Nonmydriatic: 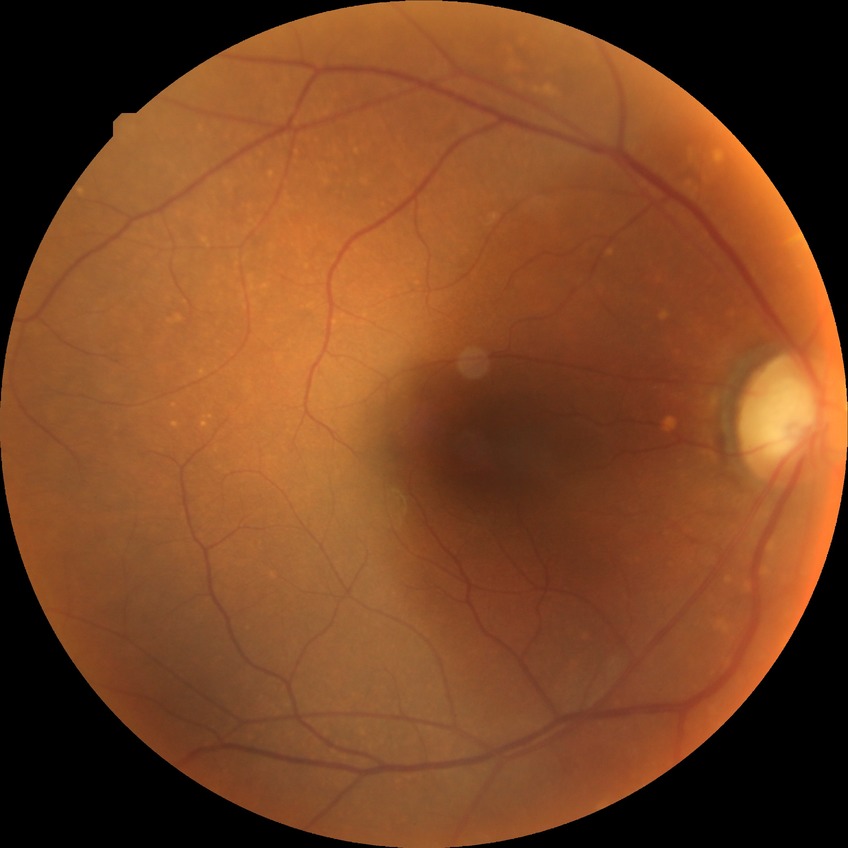

Diabetic retinopathy (DR): no diabetic retinopathy (NDR).